45° FOV:
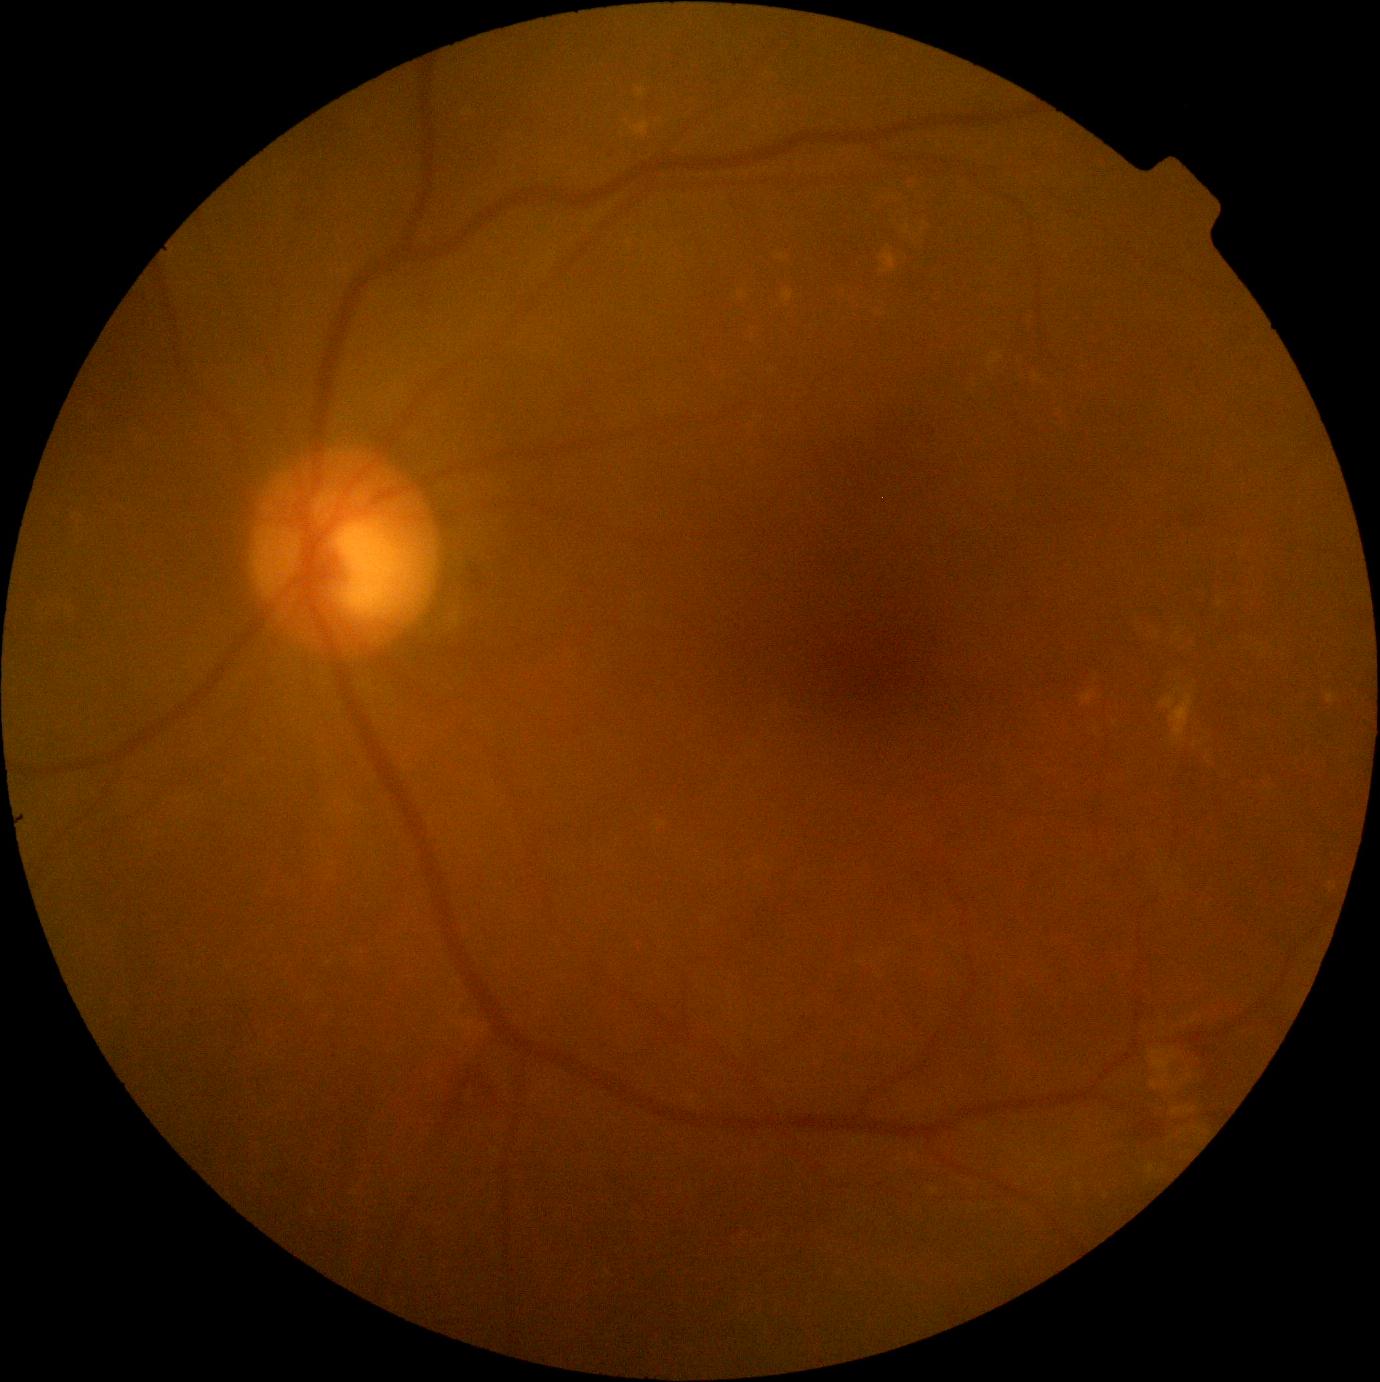 Diabetic retinopathy is grade 2 (moderate NPDR).
Disease class: non-proliferative diabetic retinopathy.